DR severity per modified Davis staging.
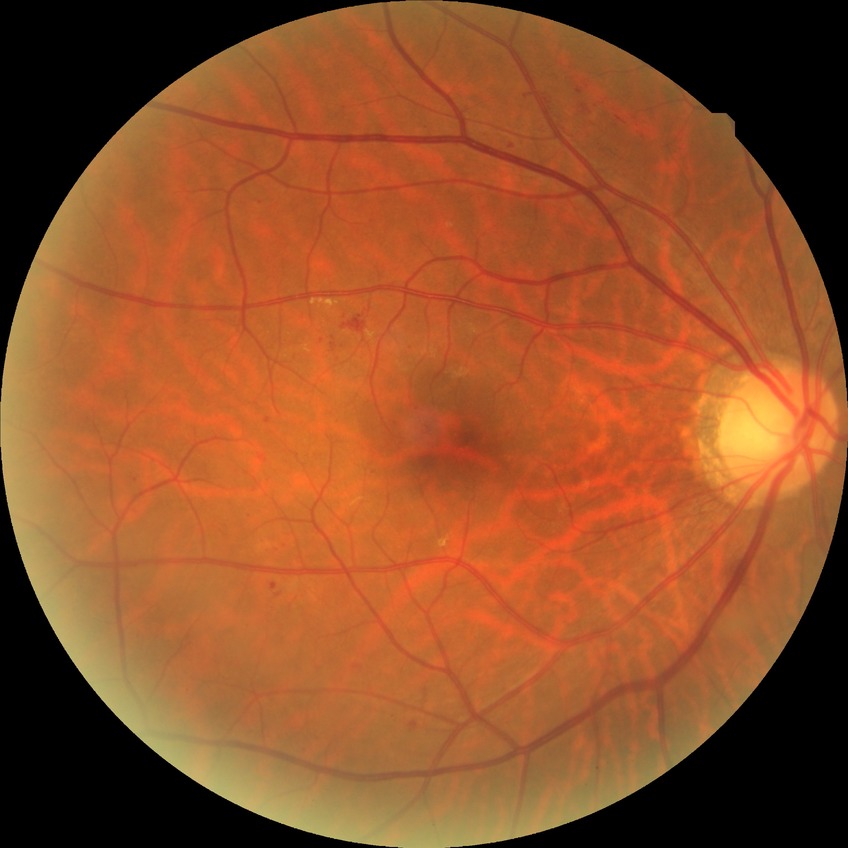

DR class: non-proliferative diabetic retinopathy. Retinopathy grade is simple diabetic retinopathy.